640x480 · pediatric wide-field fundus photograph.
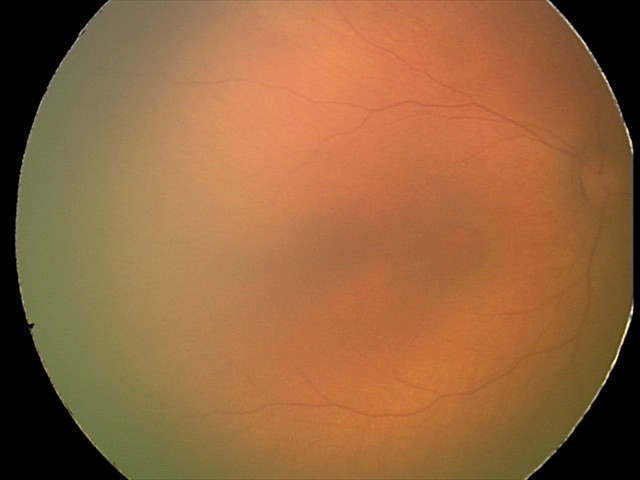

Impression = physiological appearance.